Retinal fundus photograph:
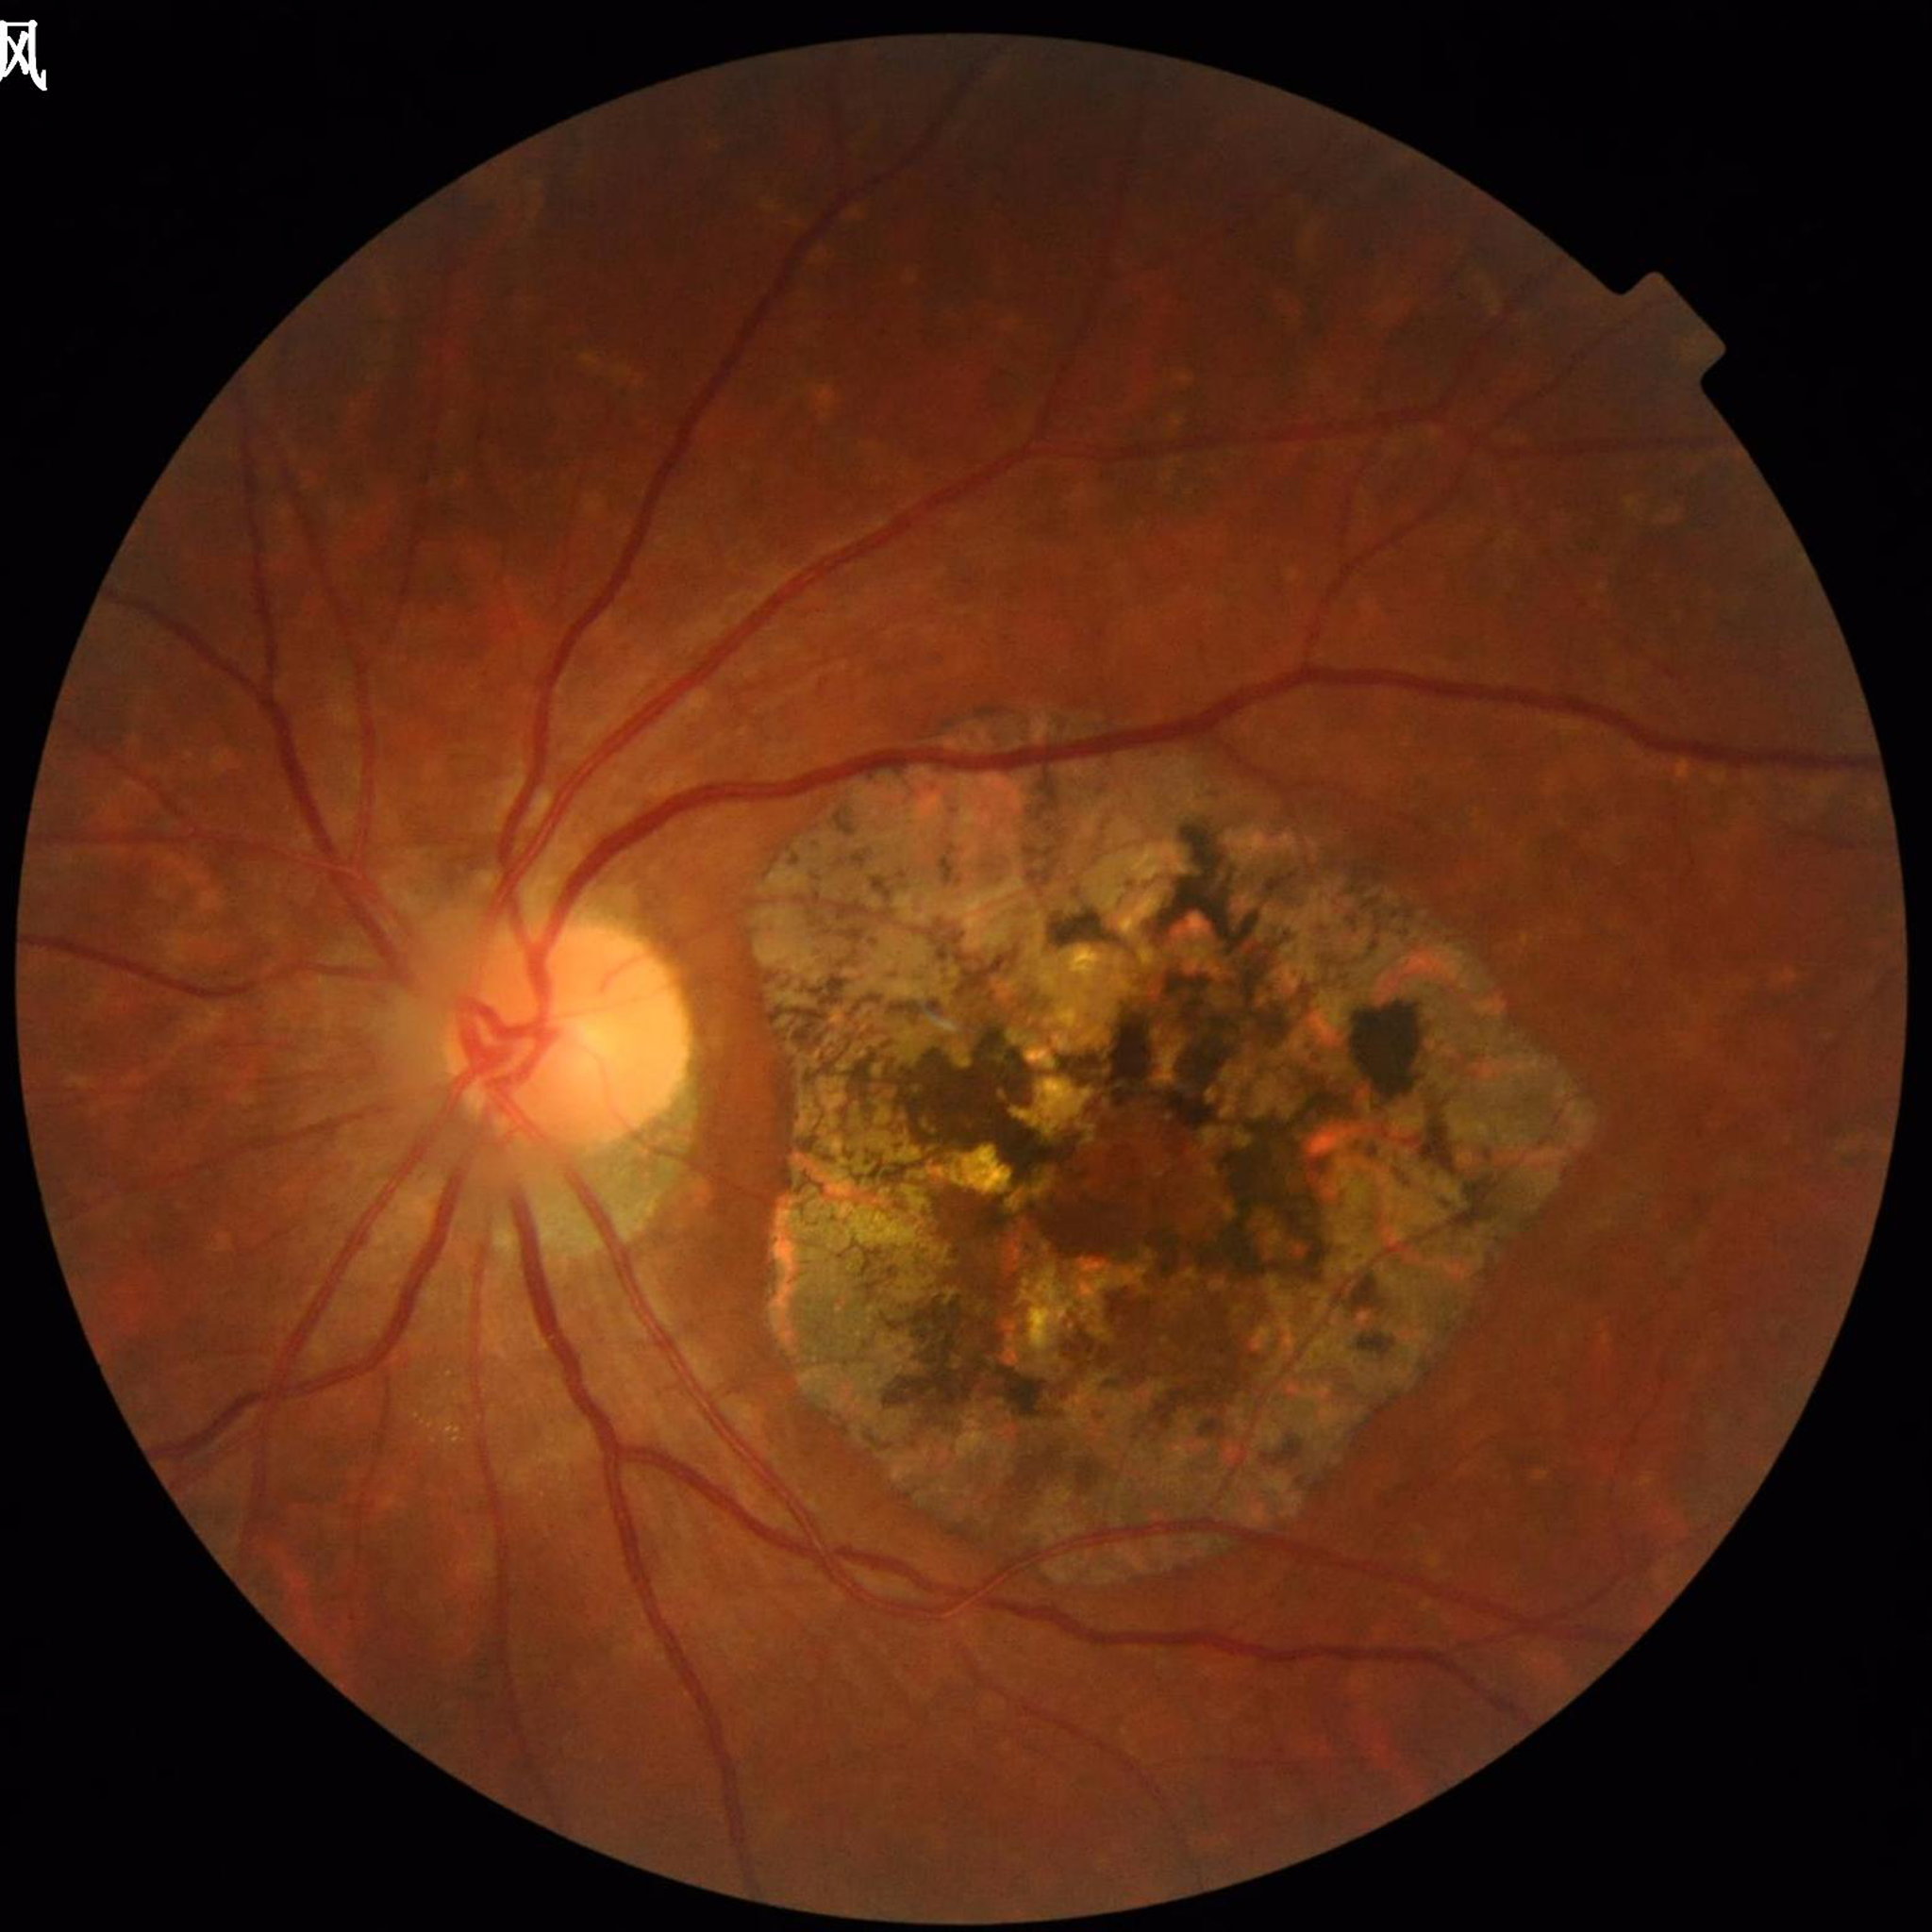 {"diagnosis": "age-related macular degeneration (AMD)"}